Nidek AFC-330
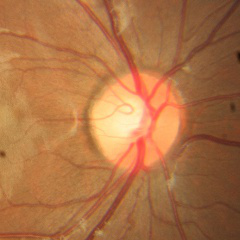

Fundus image with findings of no evidence of glaucoma.